Color fundus photograph, DR severity per modified Davis staging, 45° FOV: 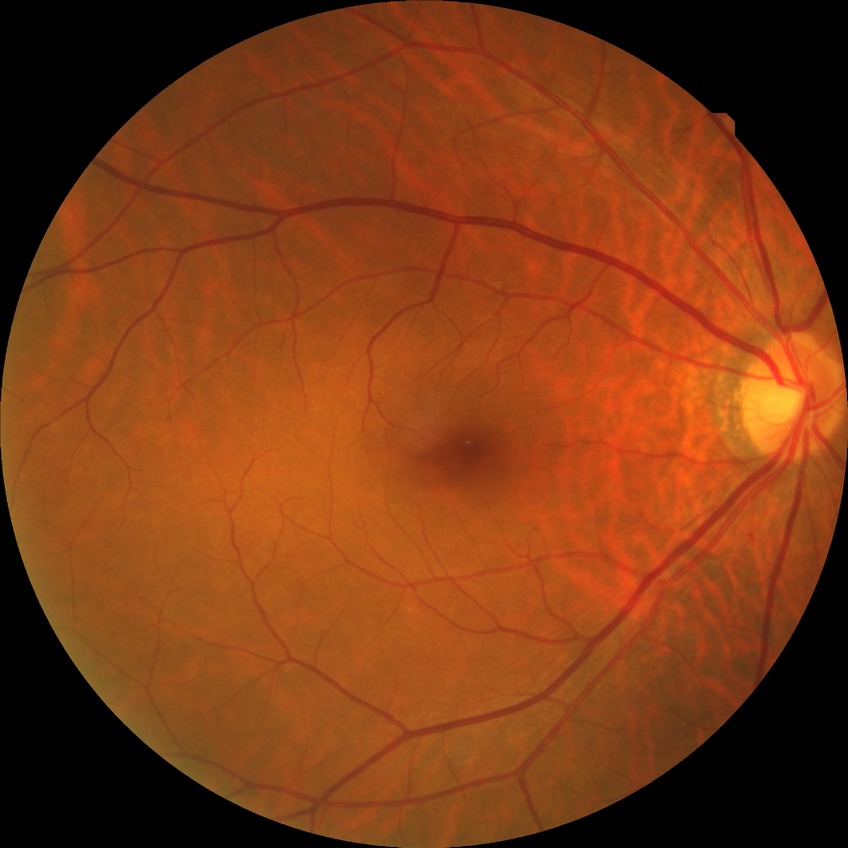
diabetic retinopathy (DR): SDR (simple diabetic retinopathy).